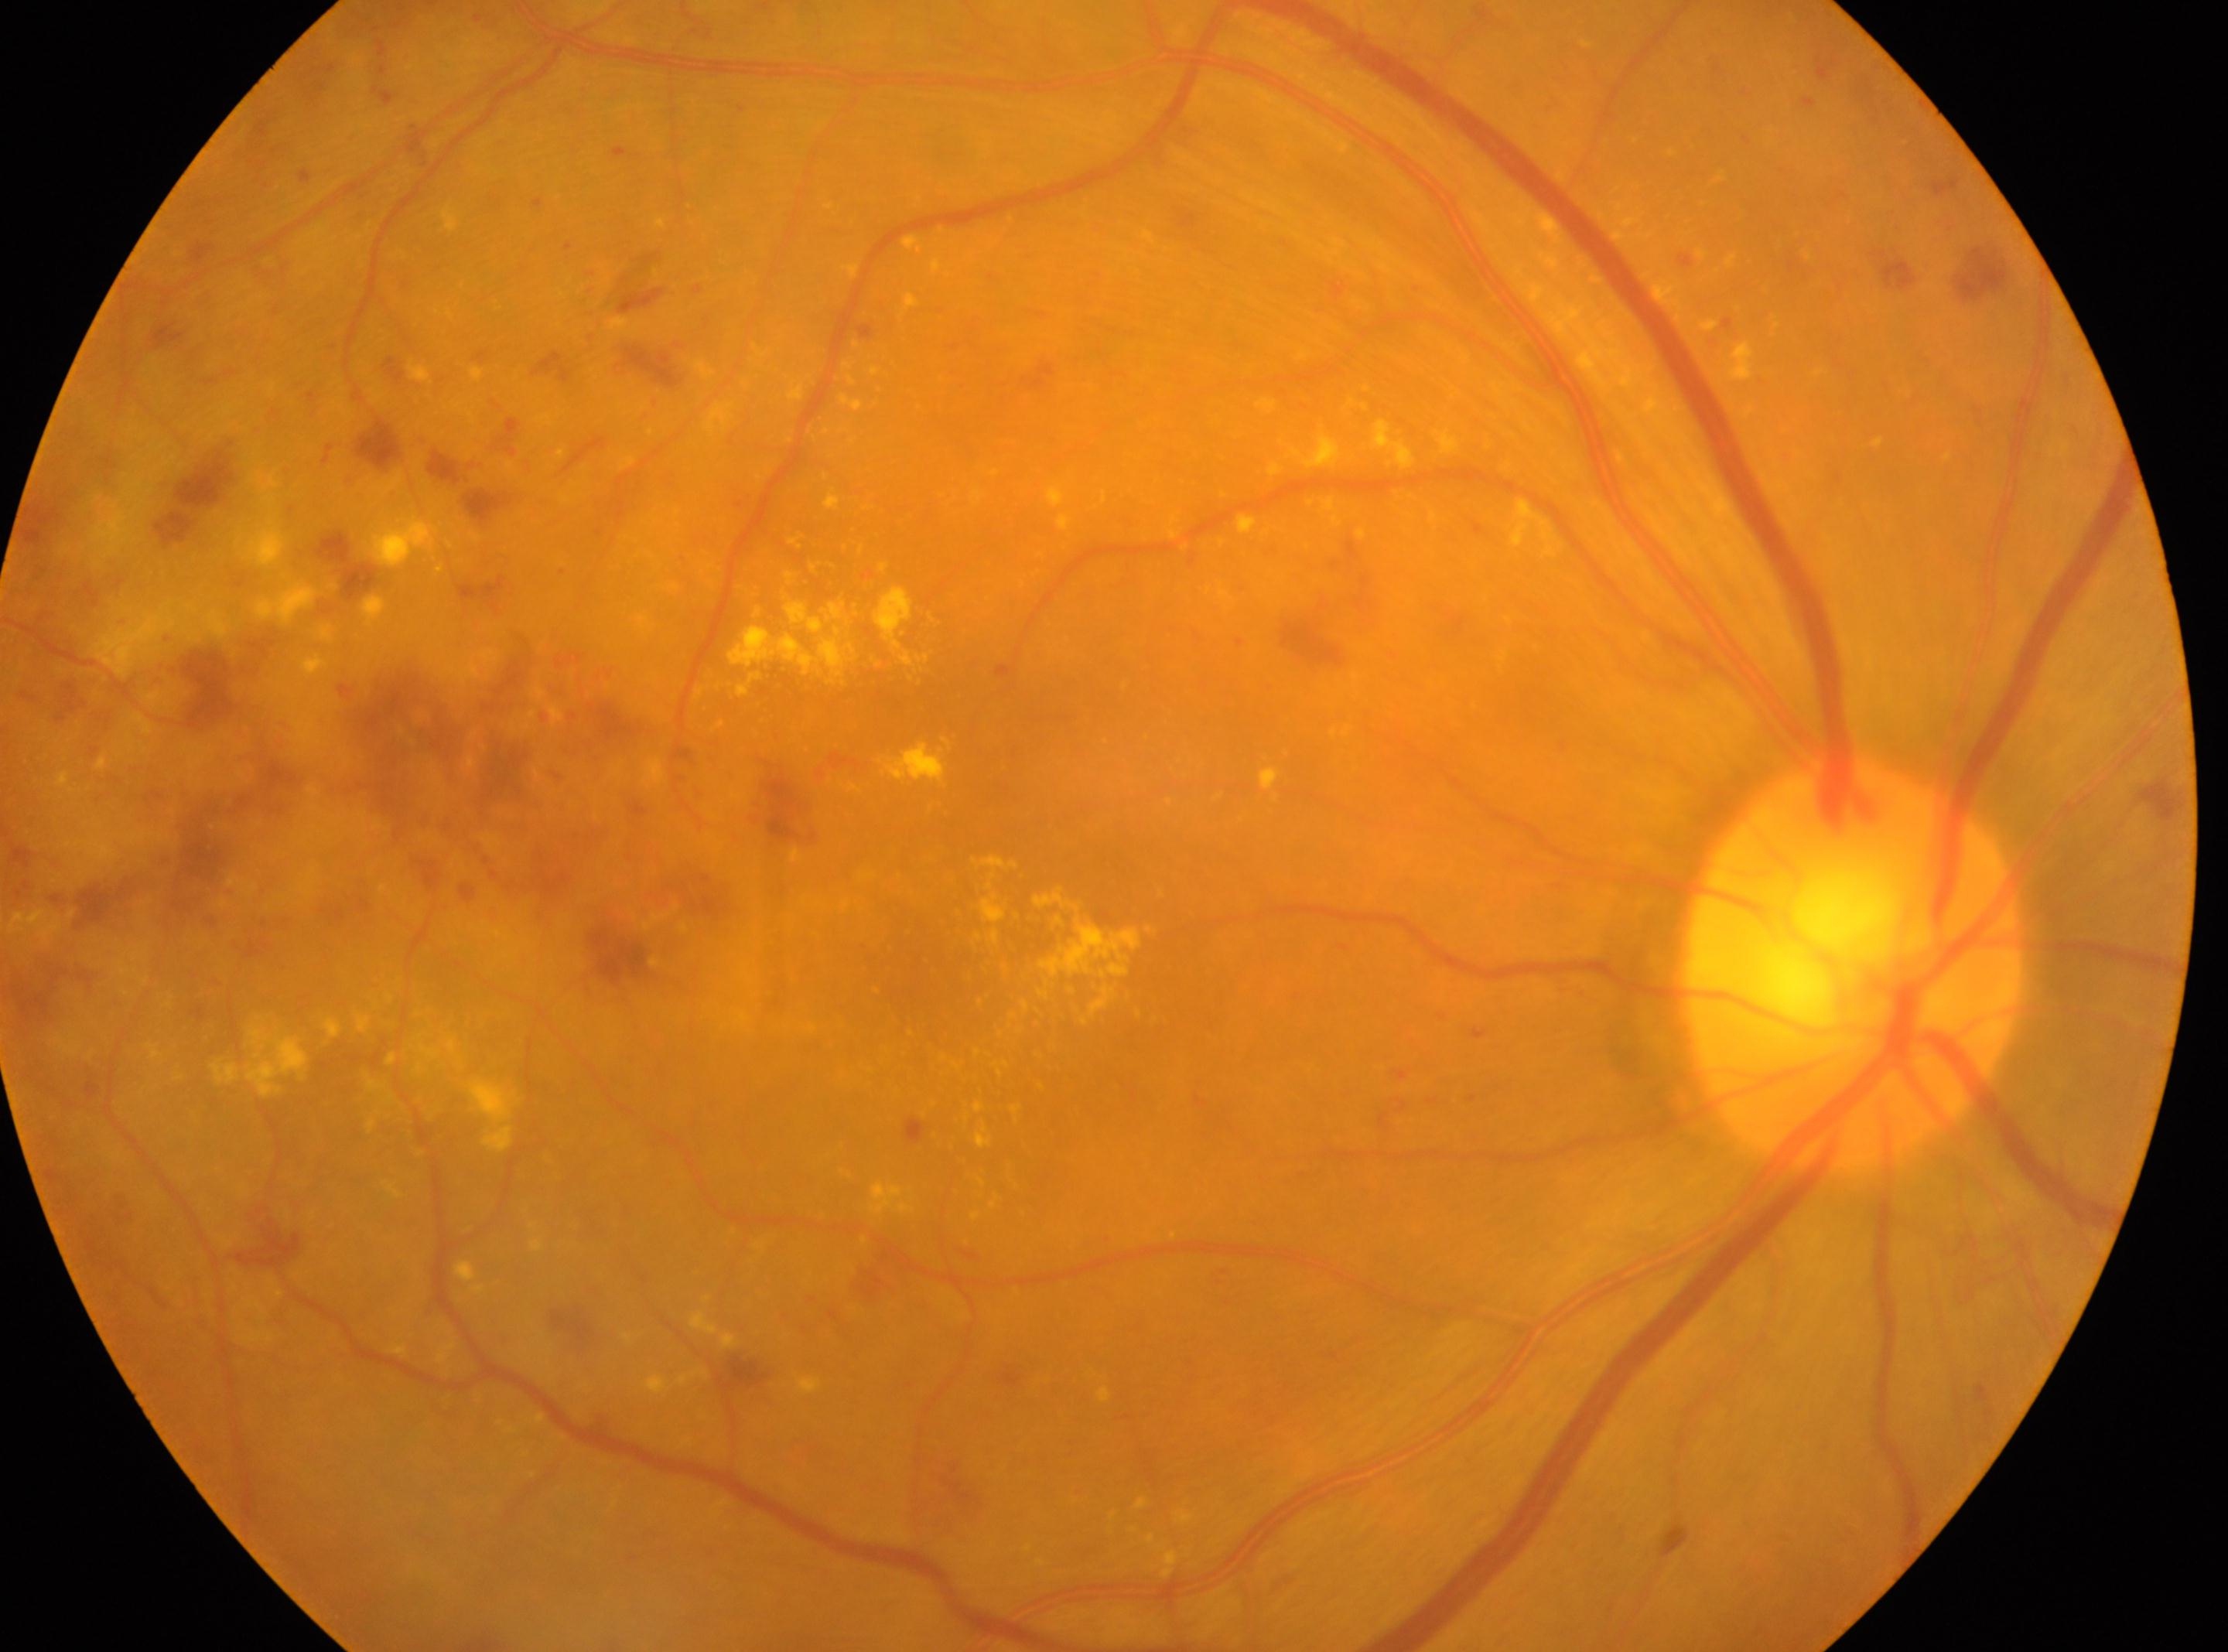   eye: the right eye
  optic_disc: [1853, 967]
  dr_grade: 2/4
  fovea: [945, 978]